50-degree field of view · fundus photo · 1924x1556.
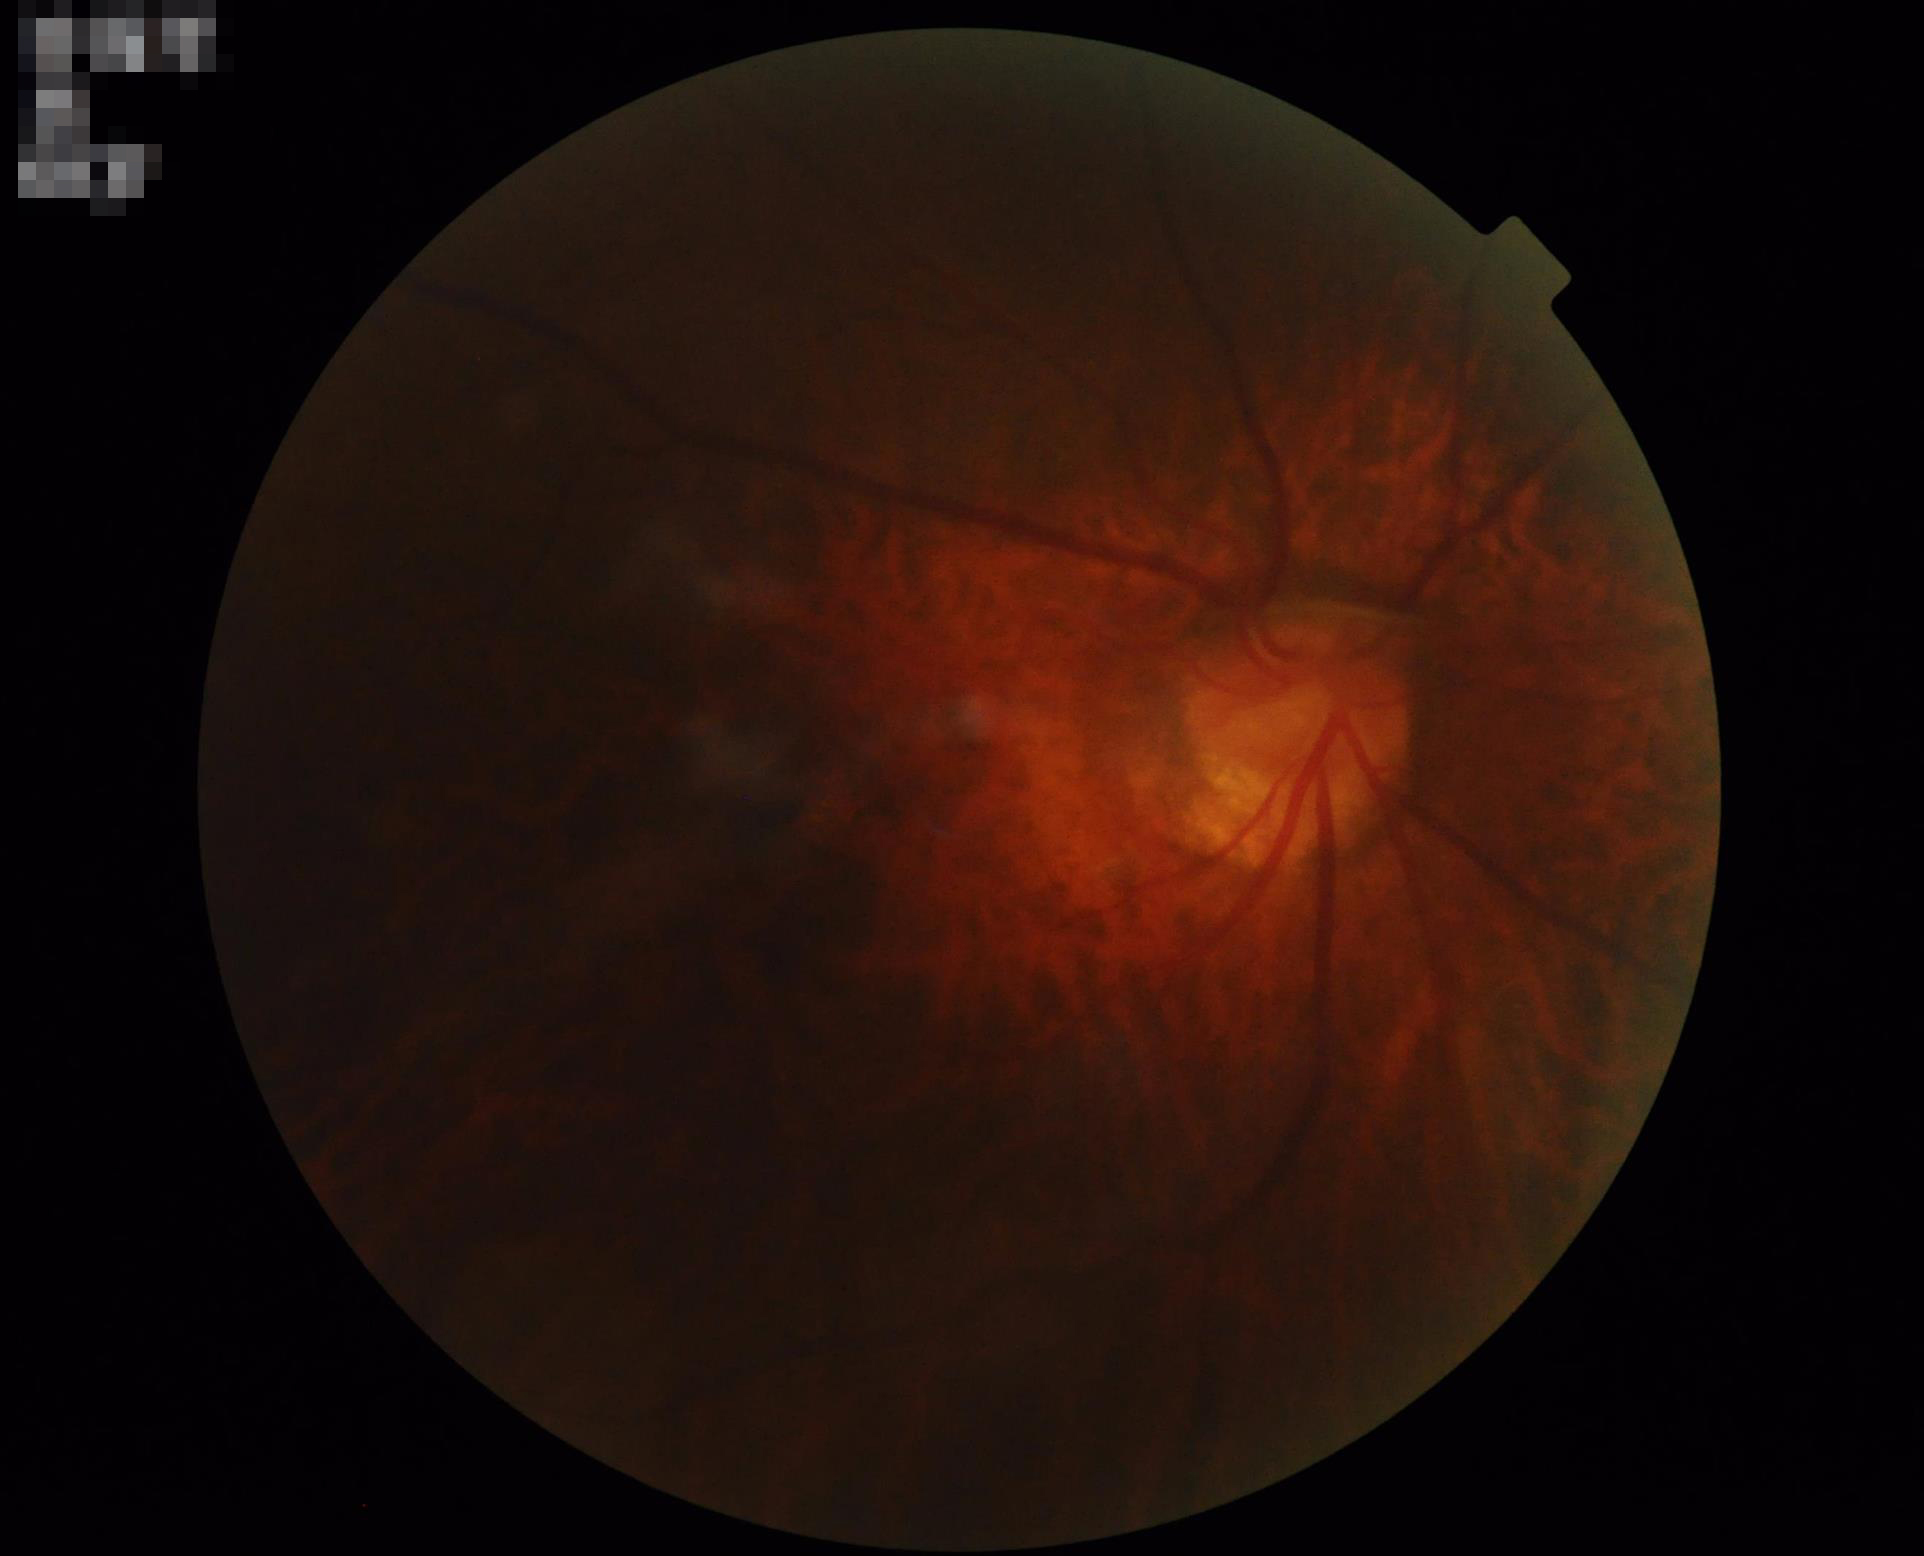
Image quality assessment:
- contrast: low
- illumination/color: poor
- overall: poor
- sharpness: out of focus